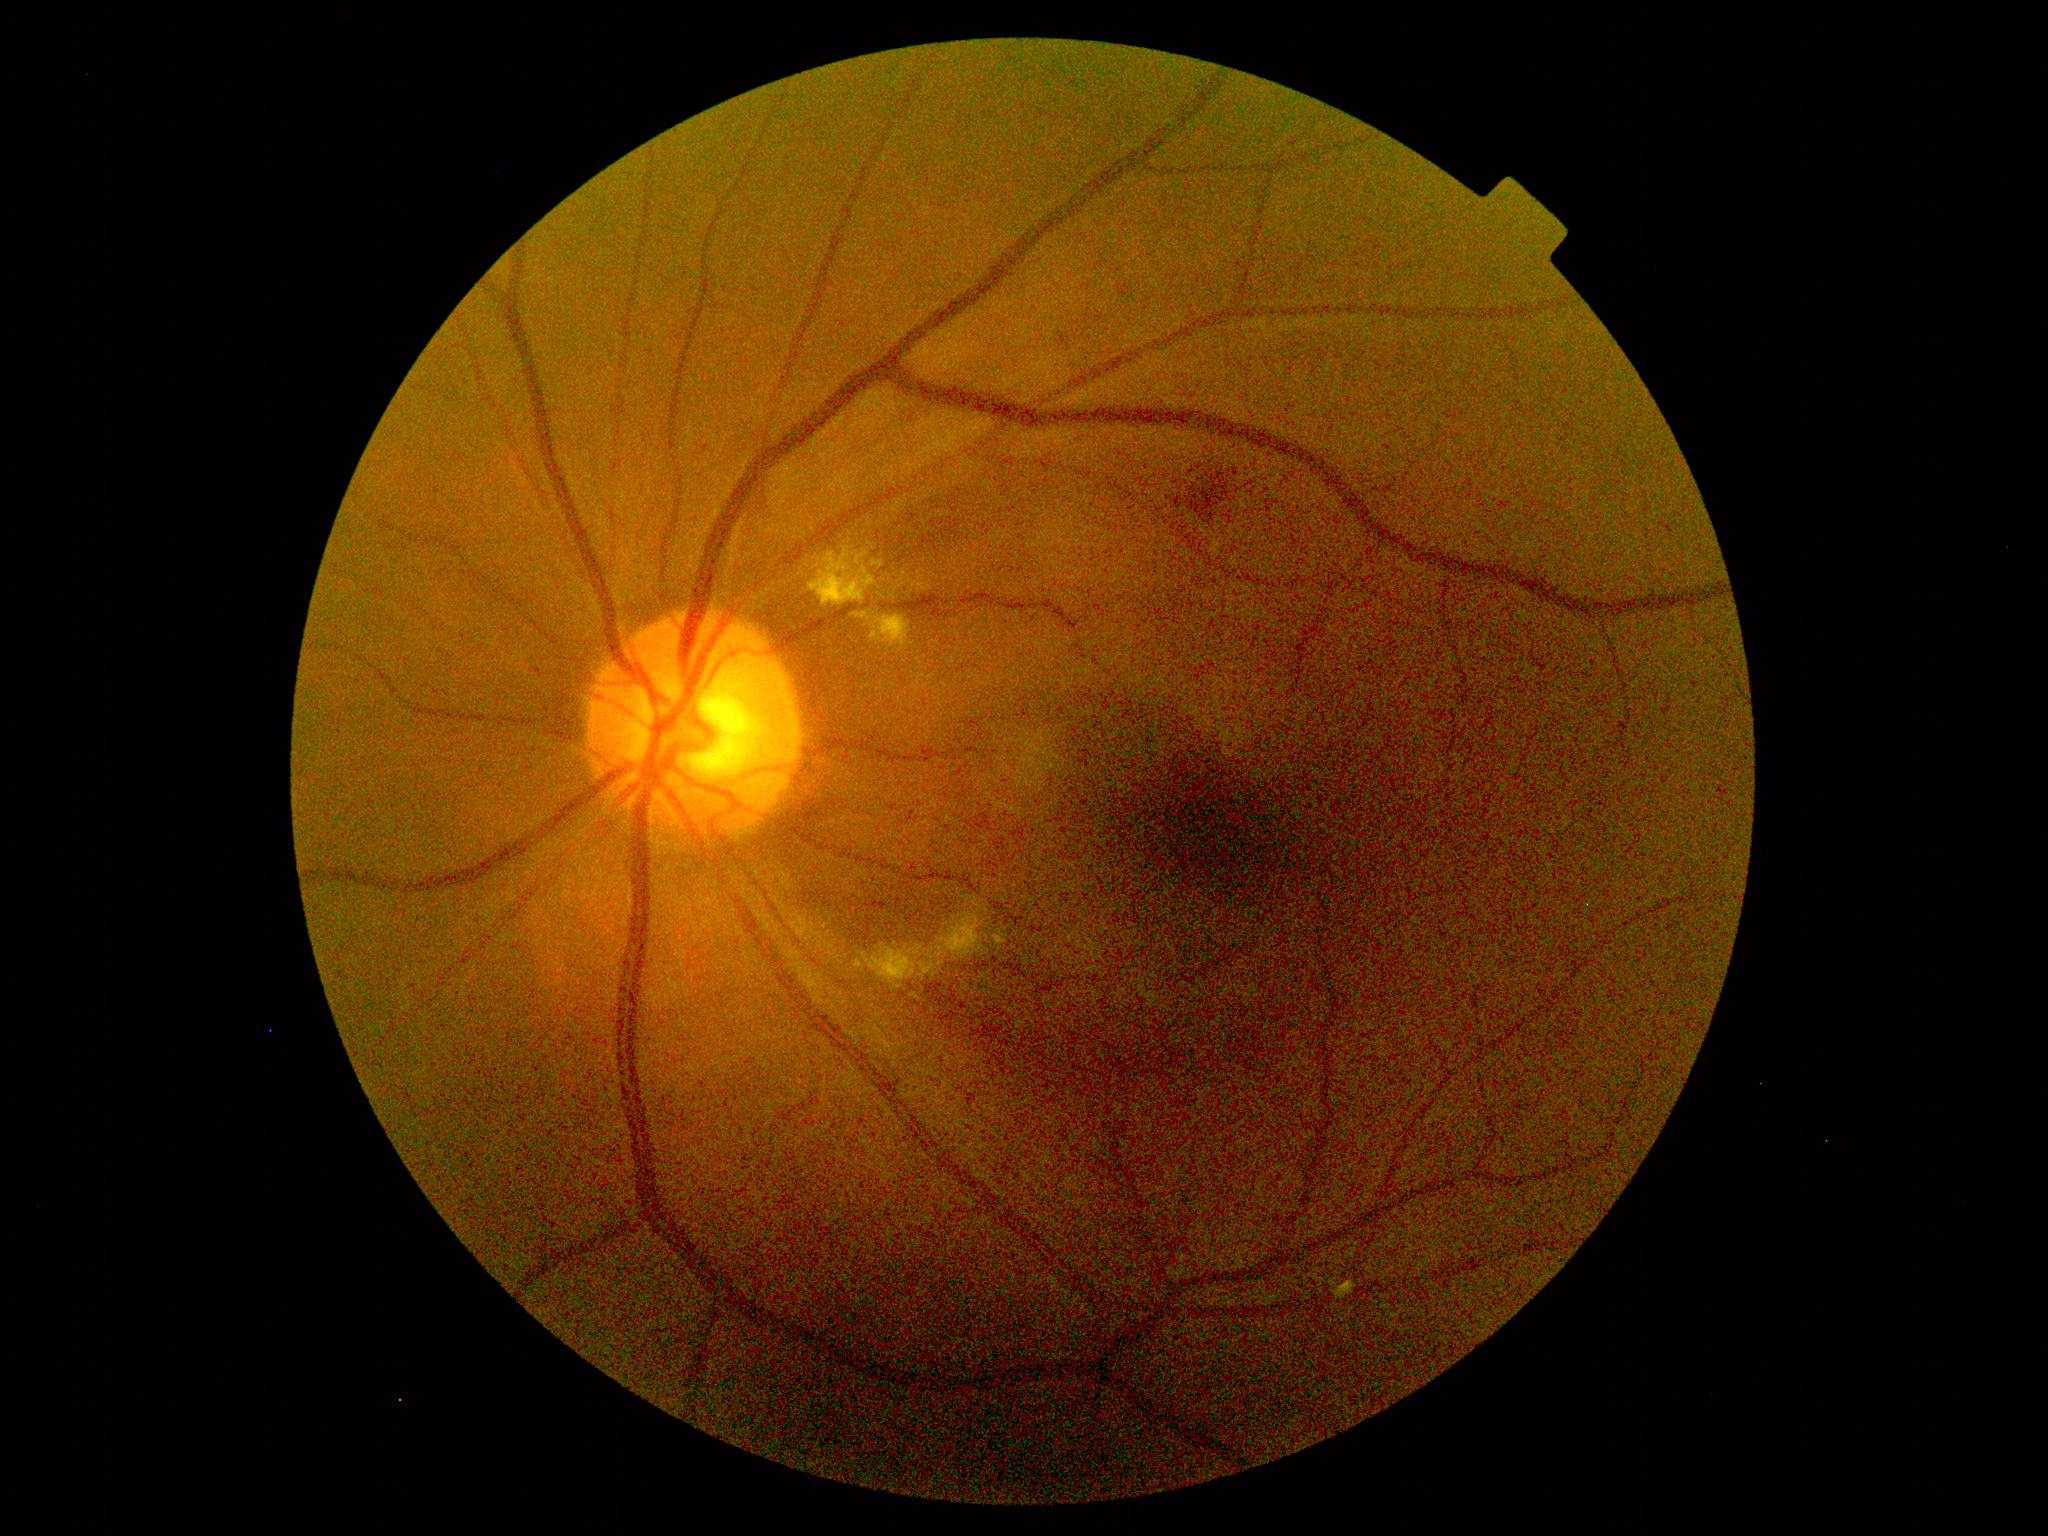 DR is grade 2 (moderate NPDR).